2352 x 1568 pixels · color fundus image — 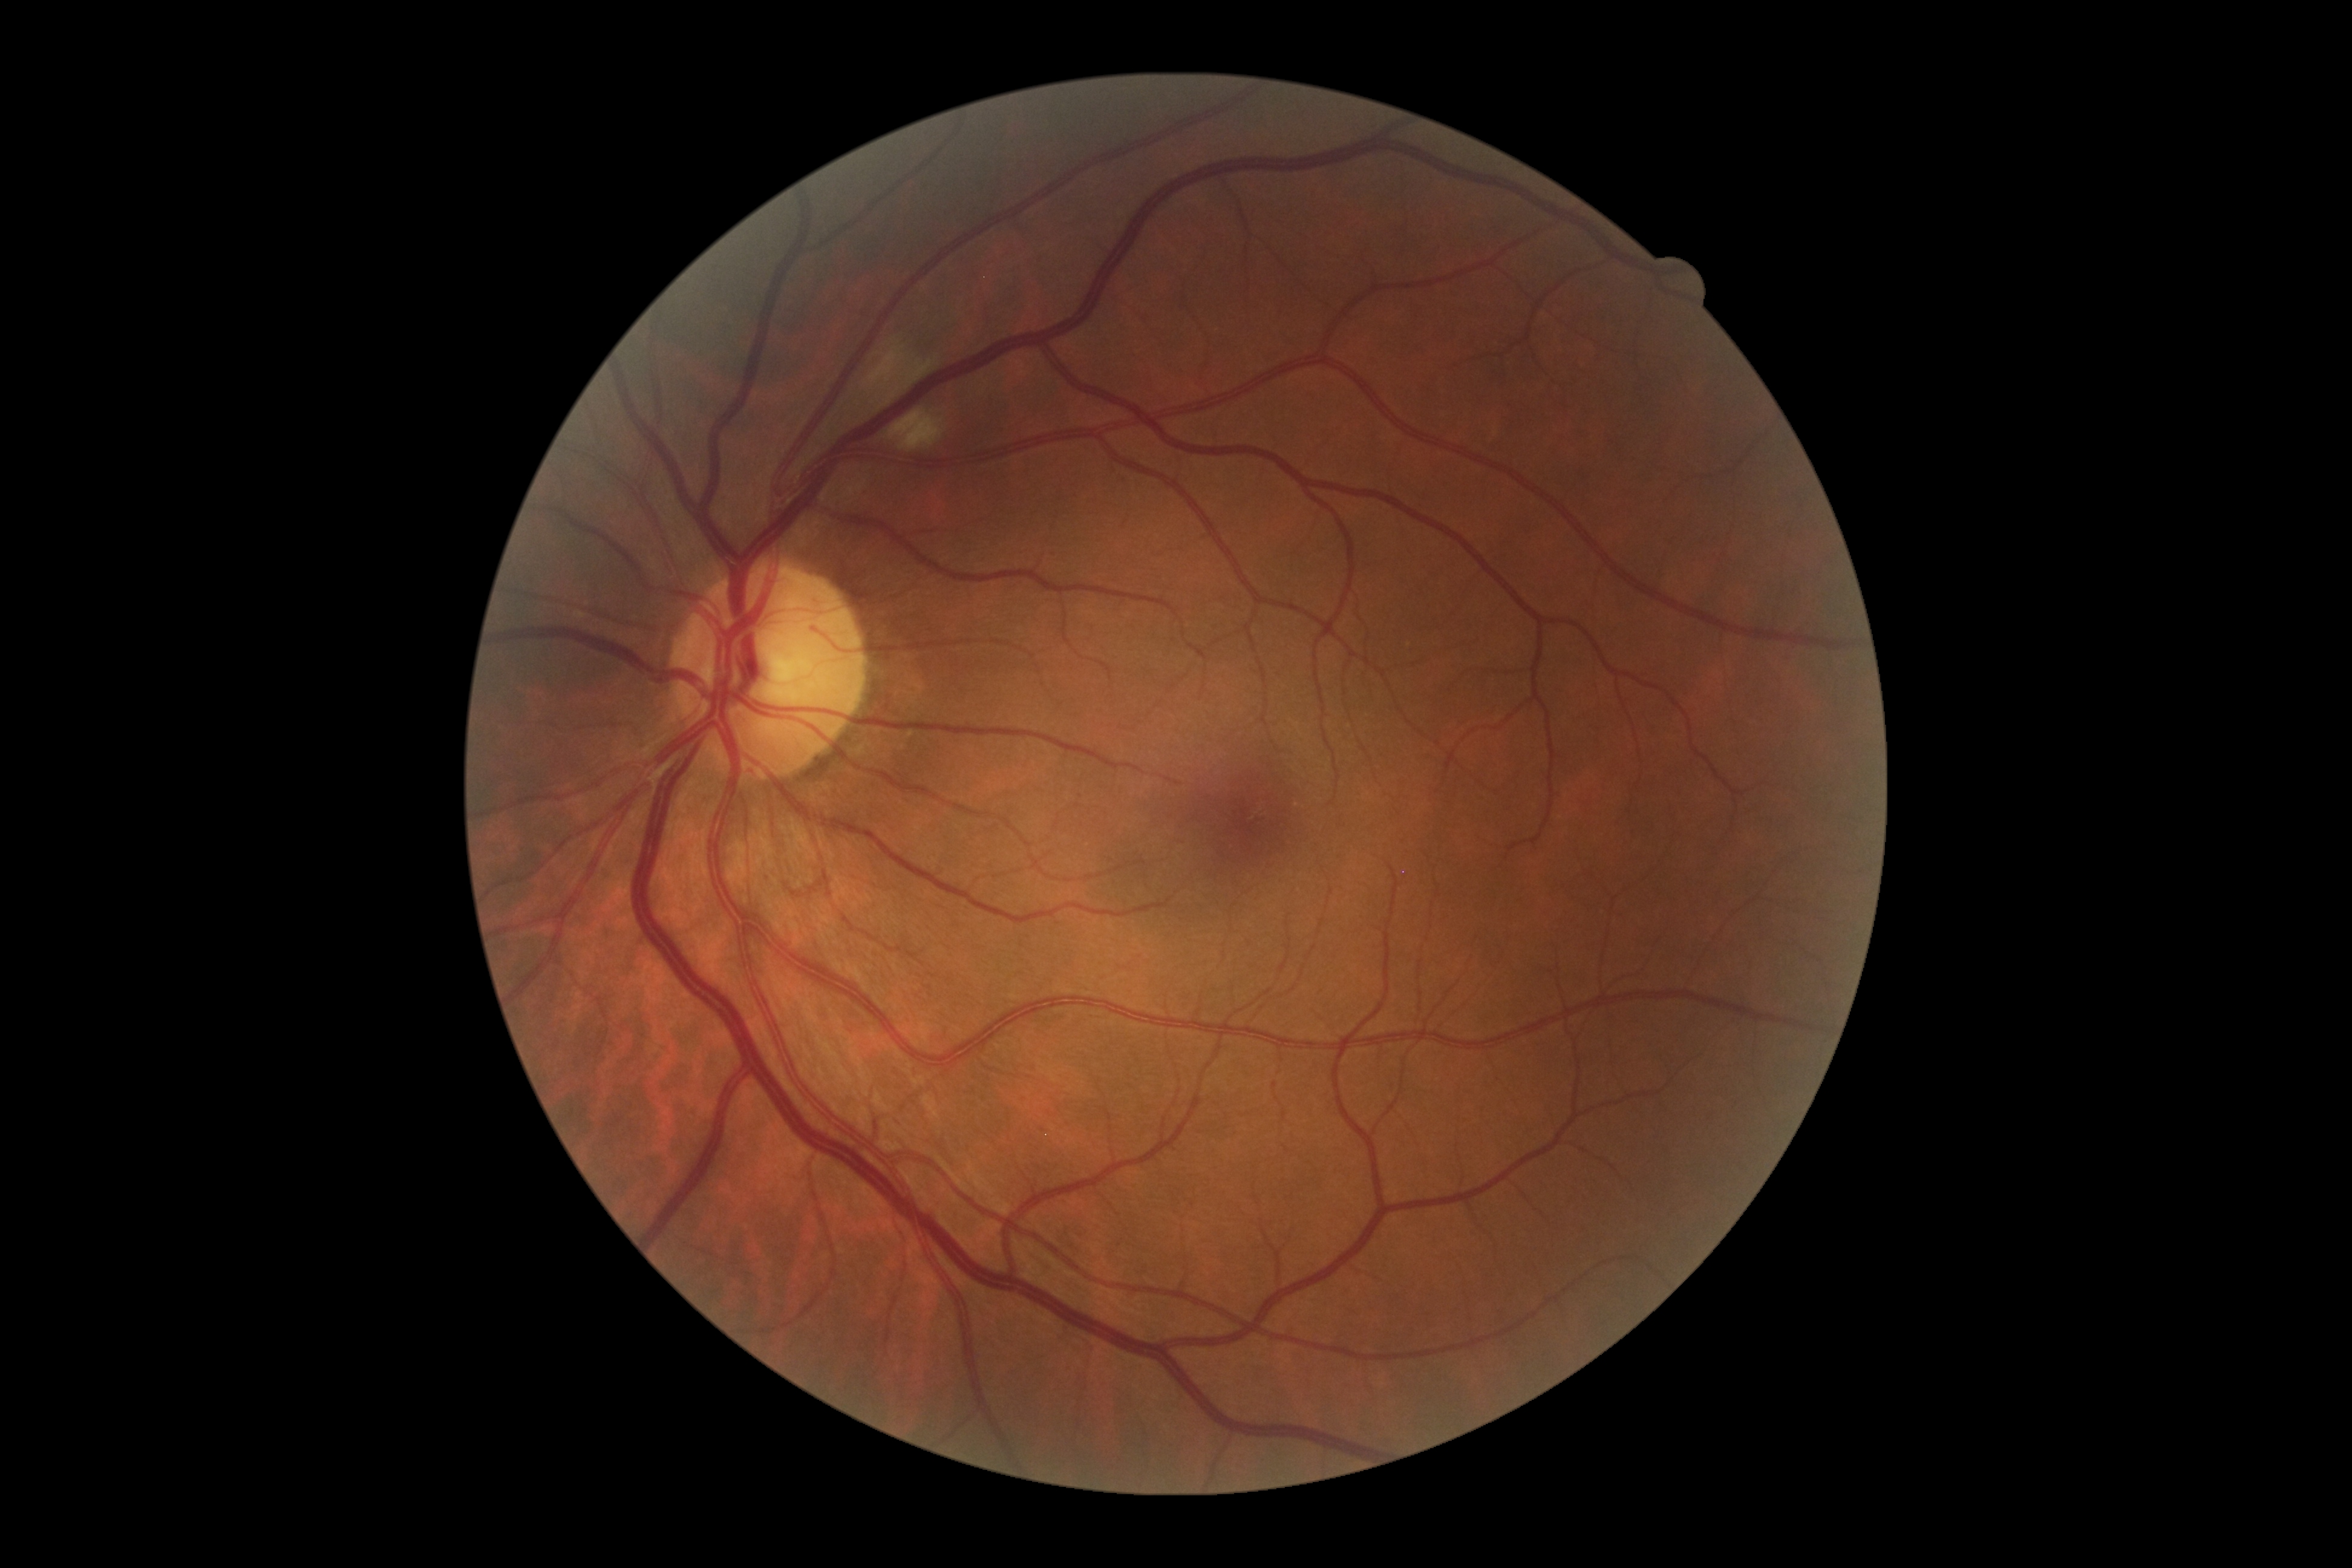 Retinopathy grade: 2 (moderate NPDR).